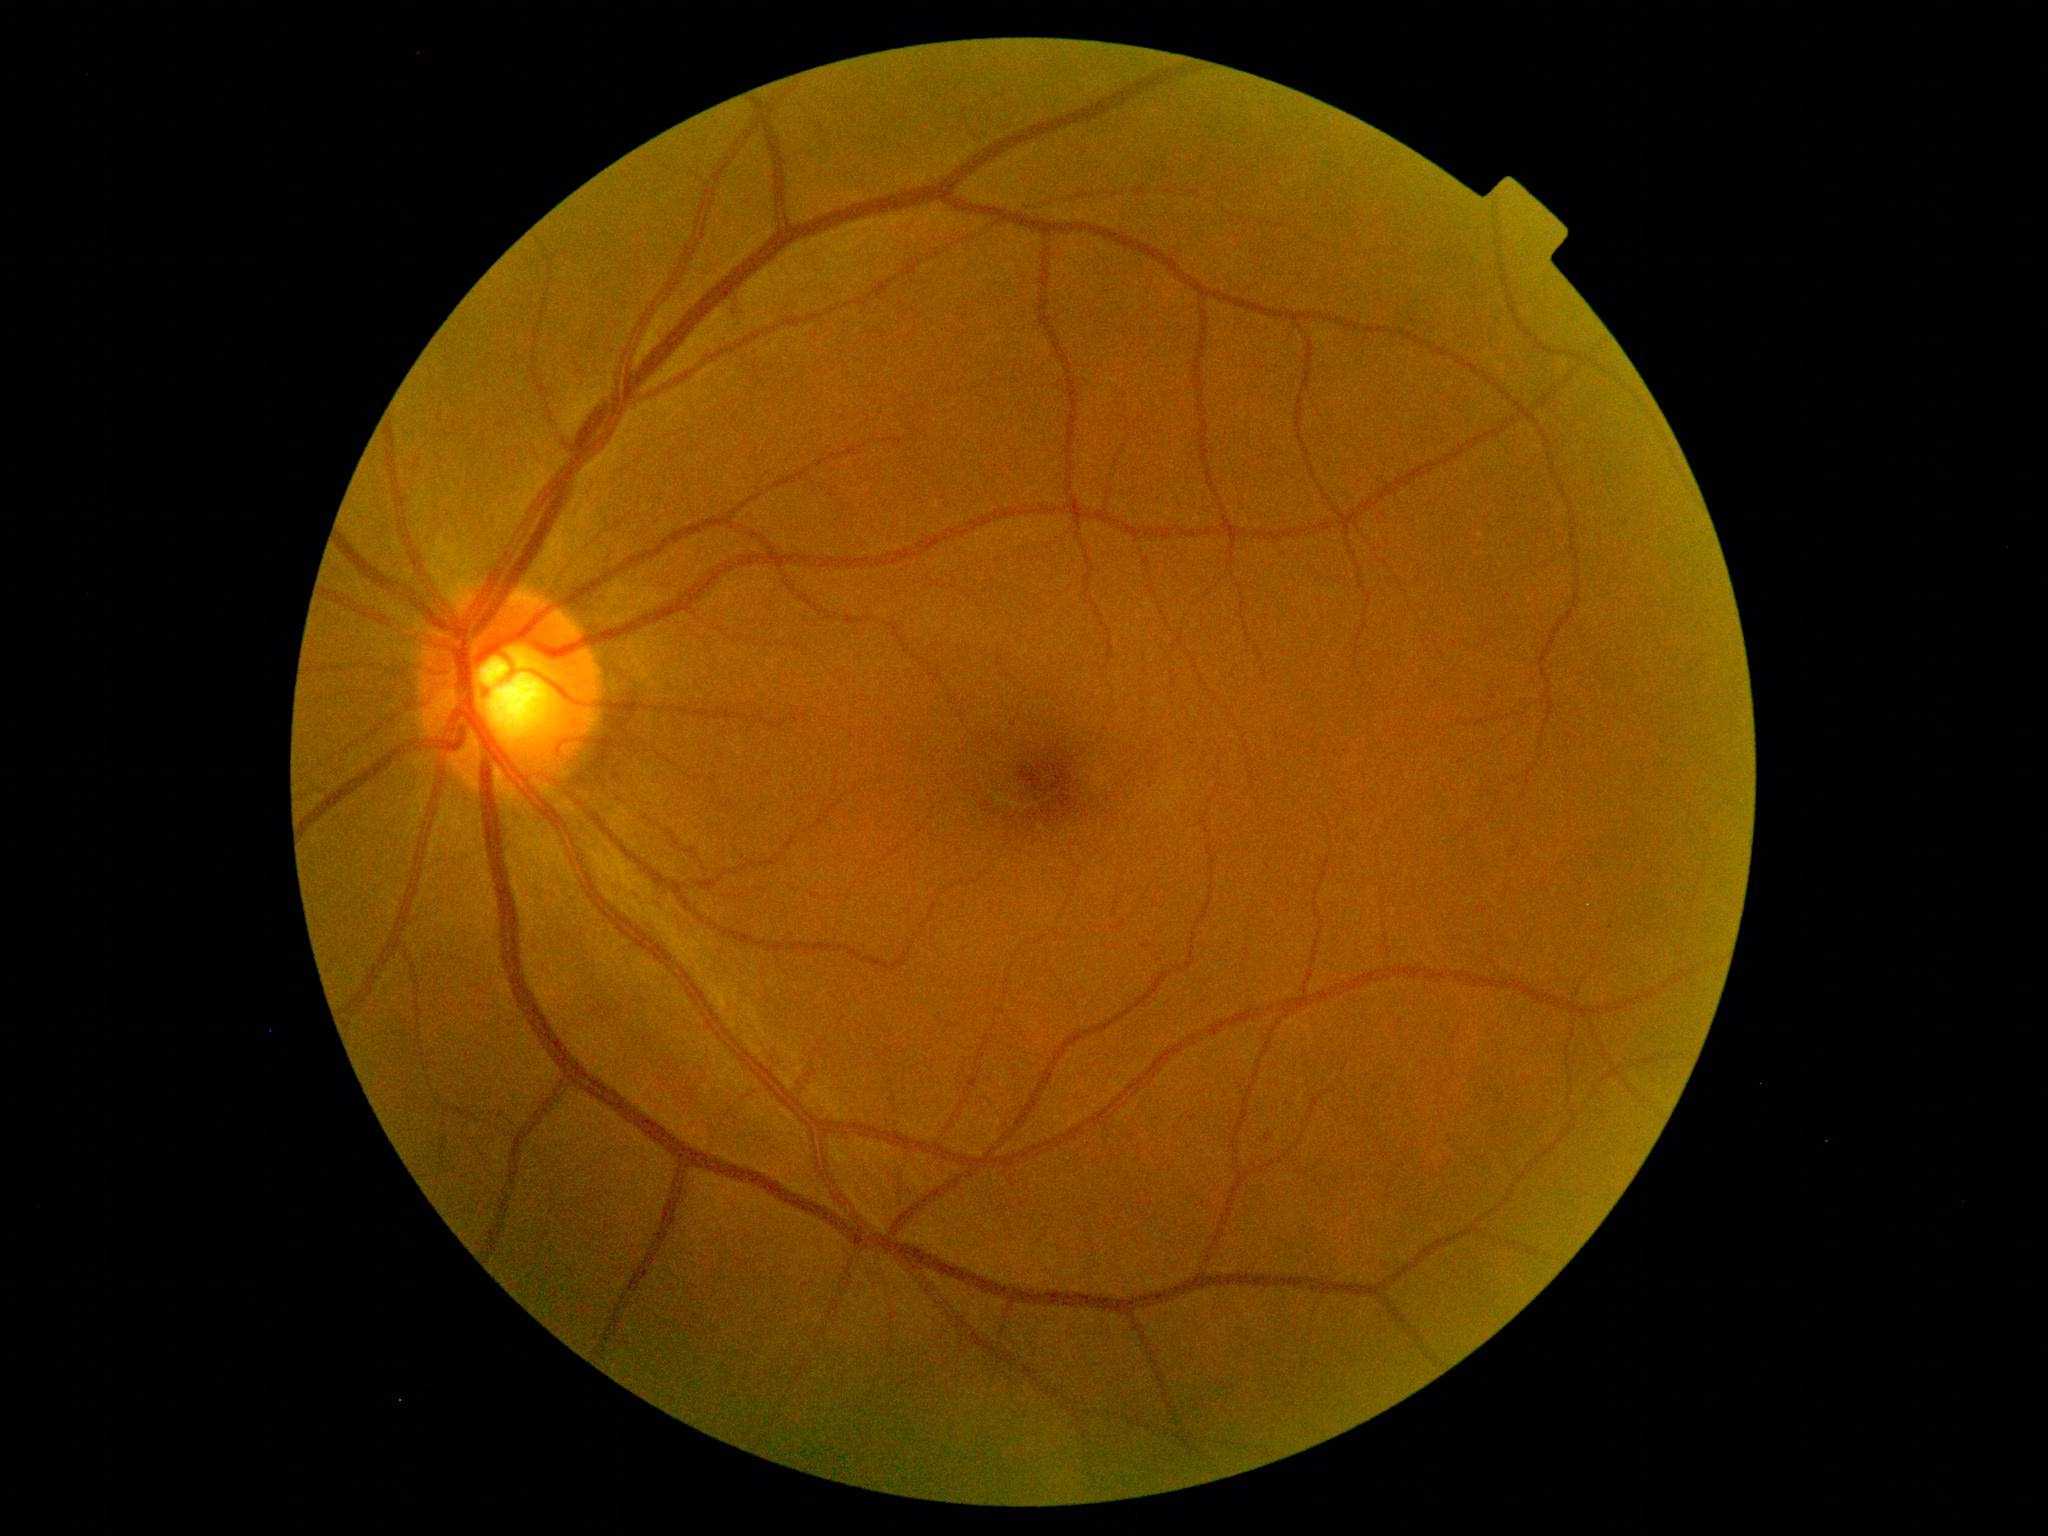 Diabetic retinopathy (DR) is grade 1.